Retinal fundus photograph. 2352 by 1568 pixels. 45° FOV: 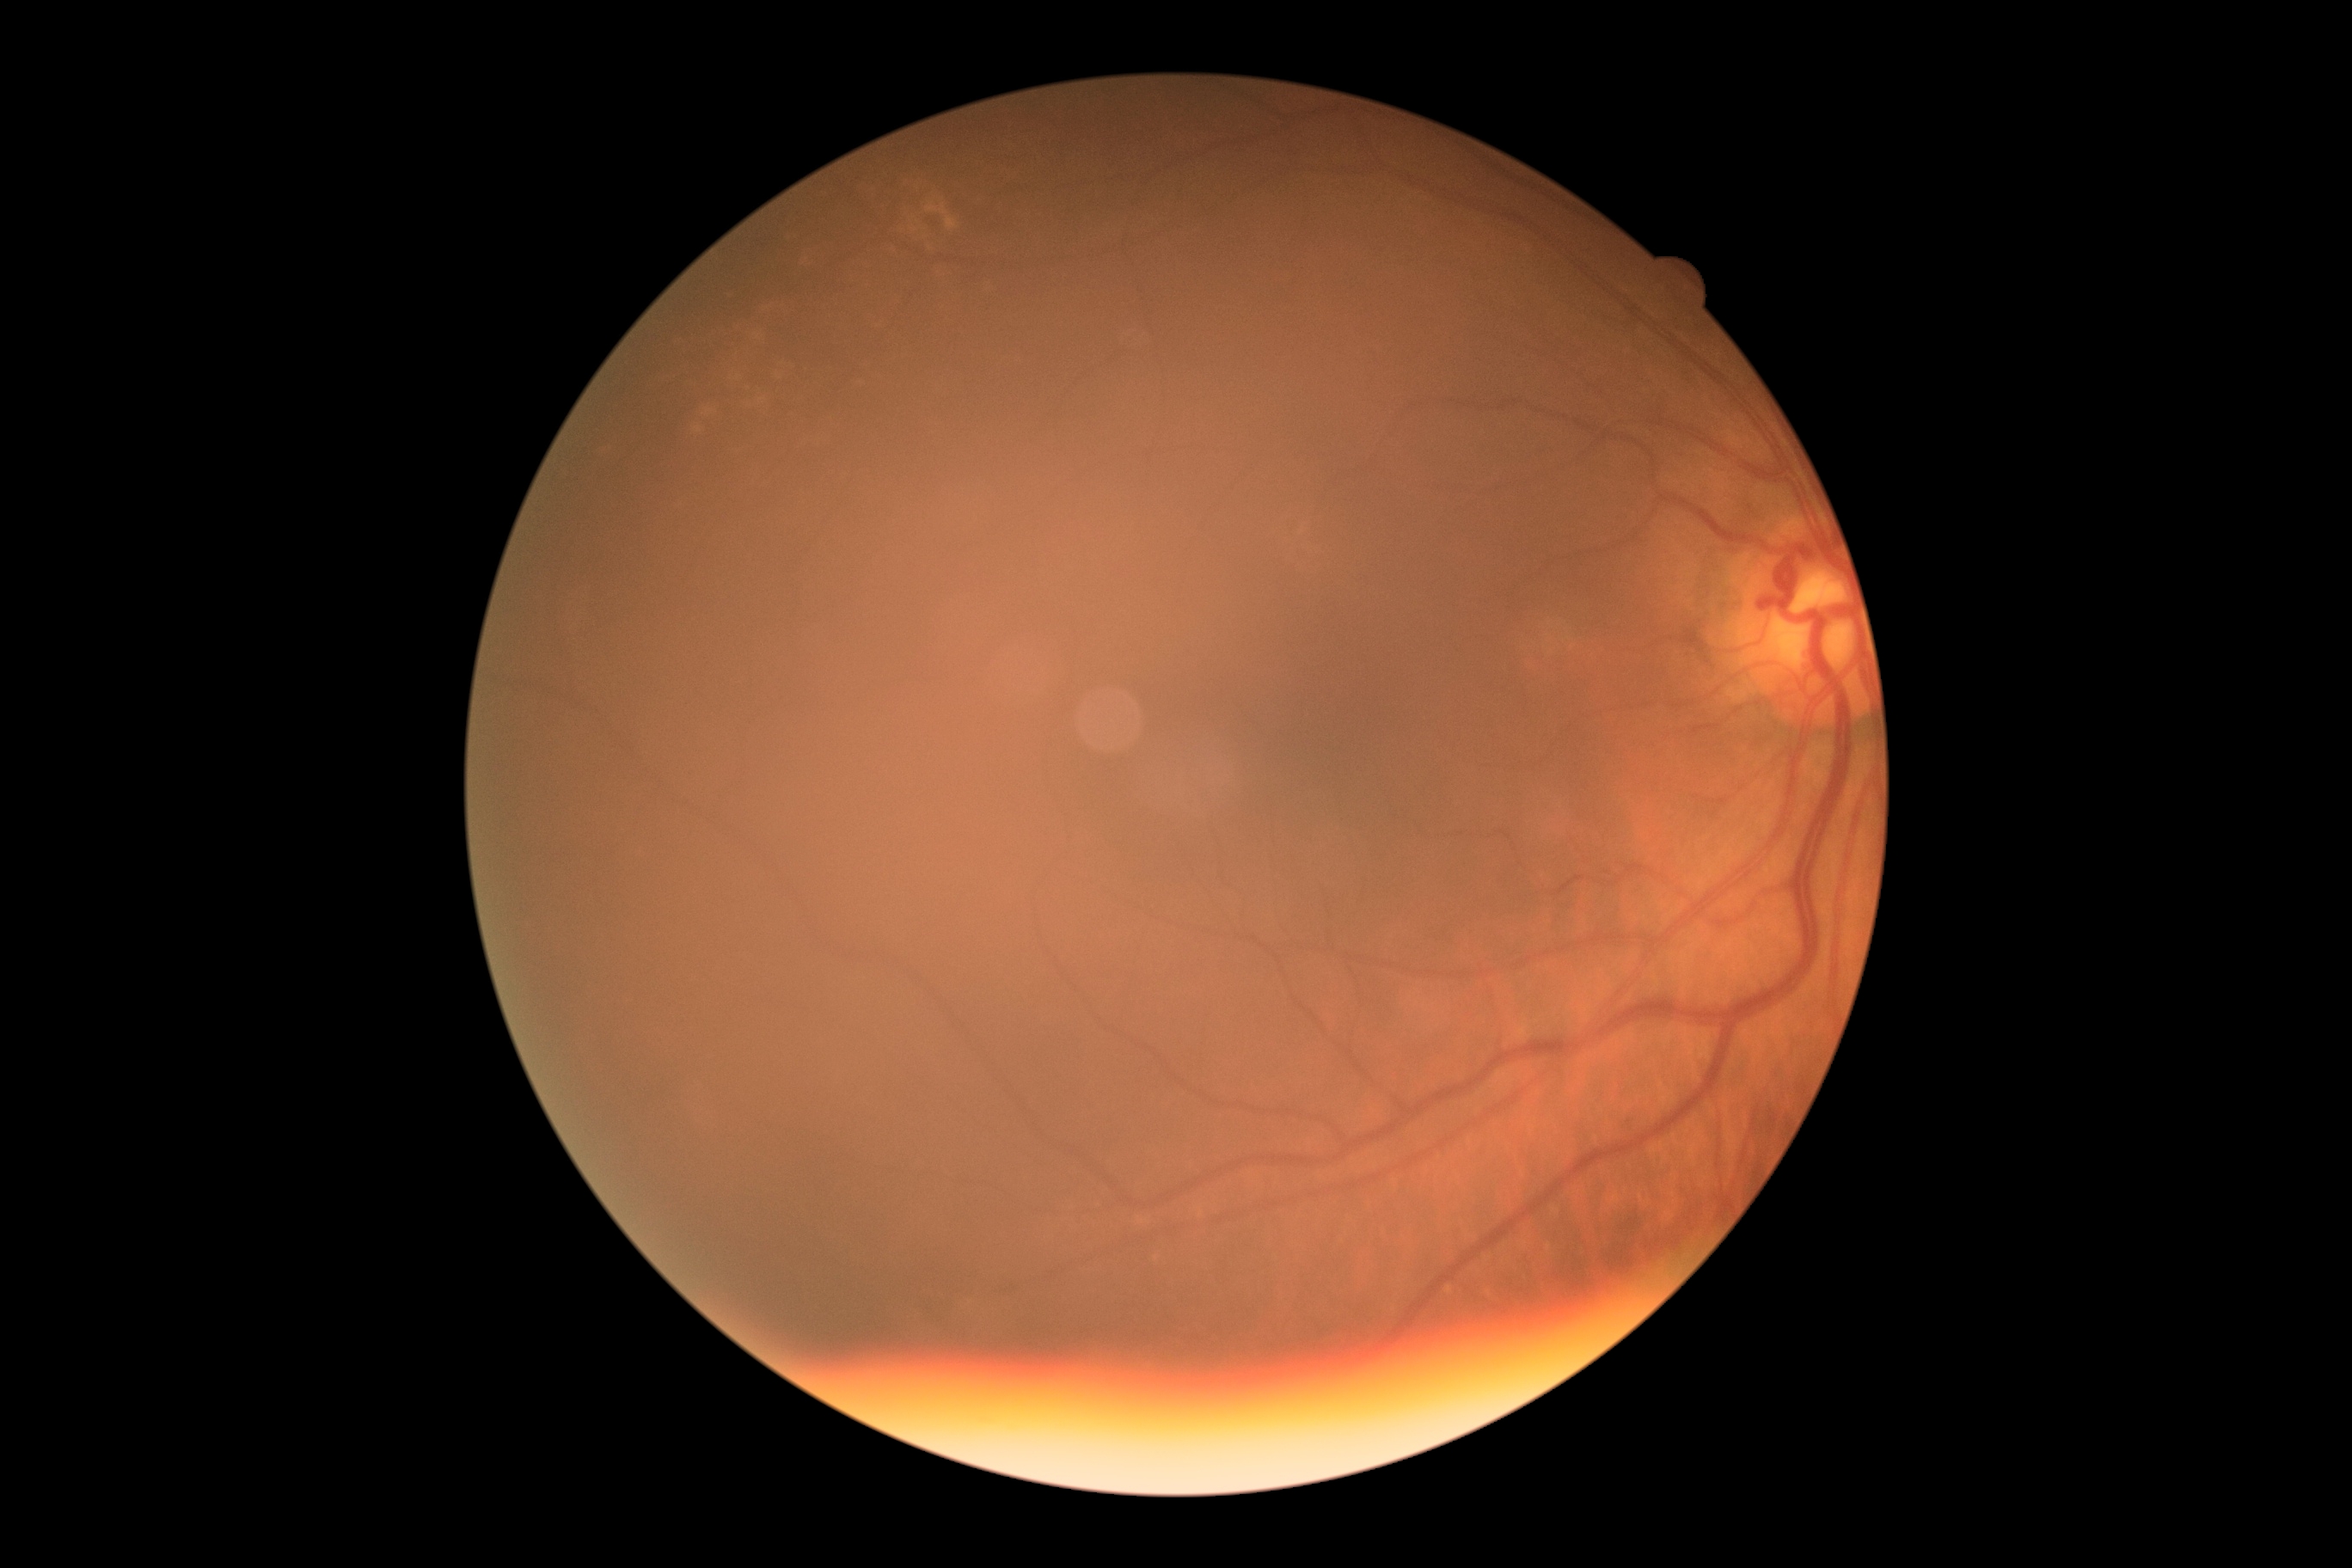
DR impression = no apparent DR
DR = grade 0 (no apparent retinopathy) — no visible signs of diabetic retinopathy